FOV: 45 degrees; no pharmacologic dilation; color fundus image; image size 848x848 — 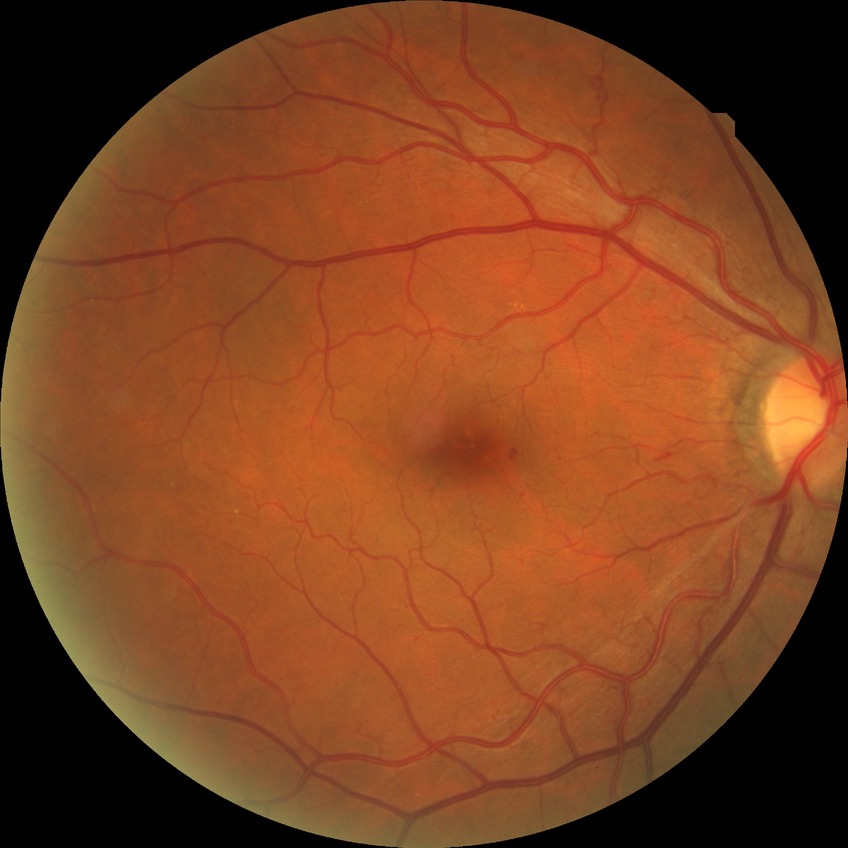

Diabetic retinopathy (DR): SDR (simple diabetic retinopathy).